Image size 2352x1568; 45° FOV; fundus photo.
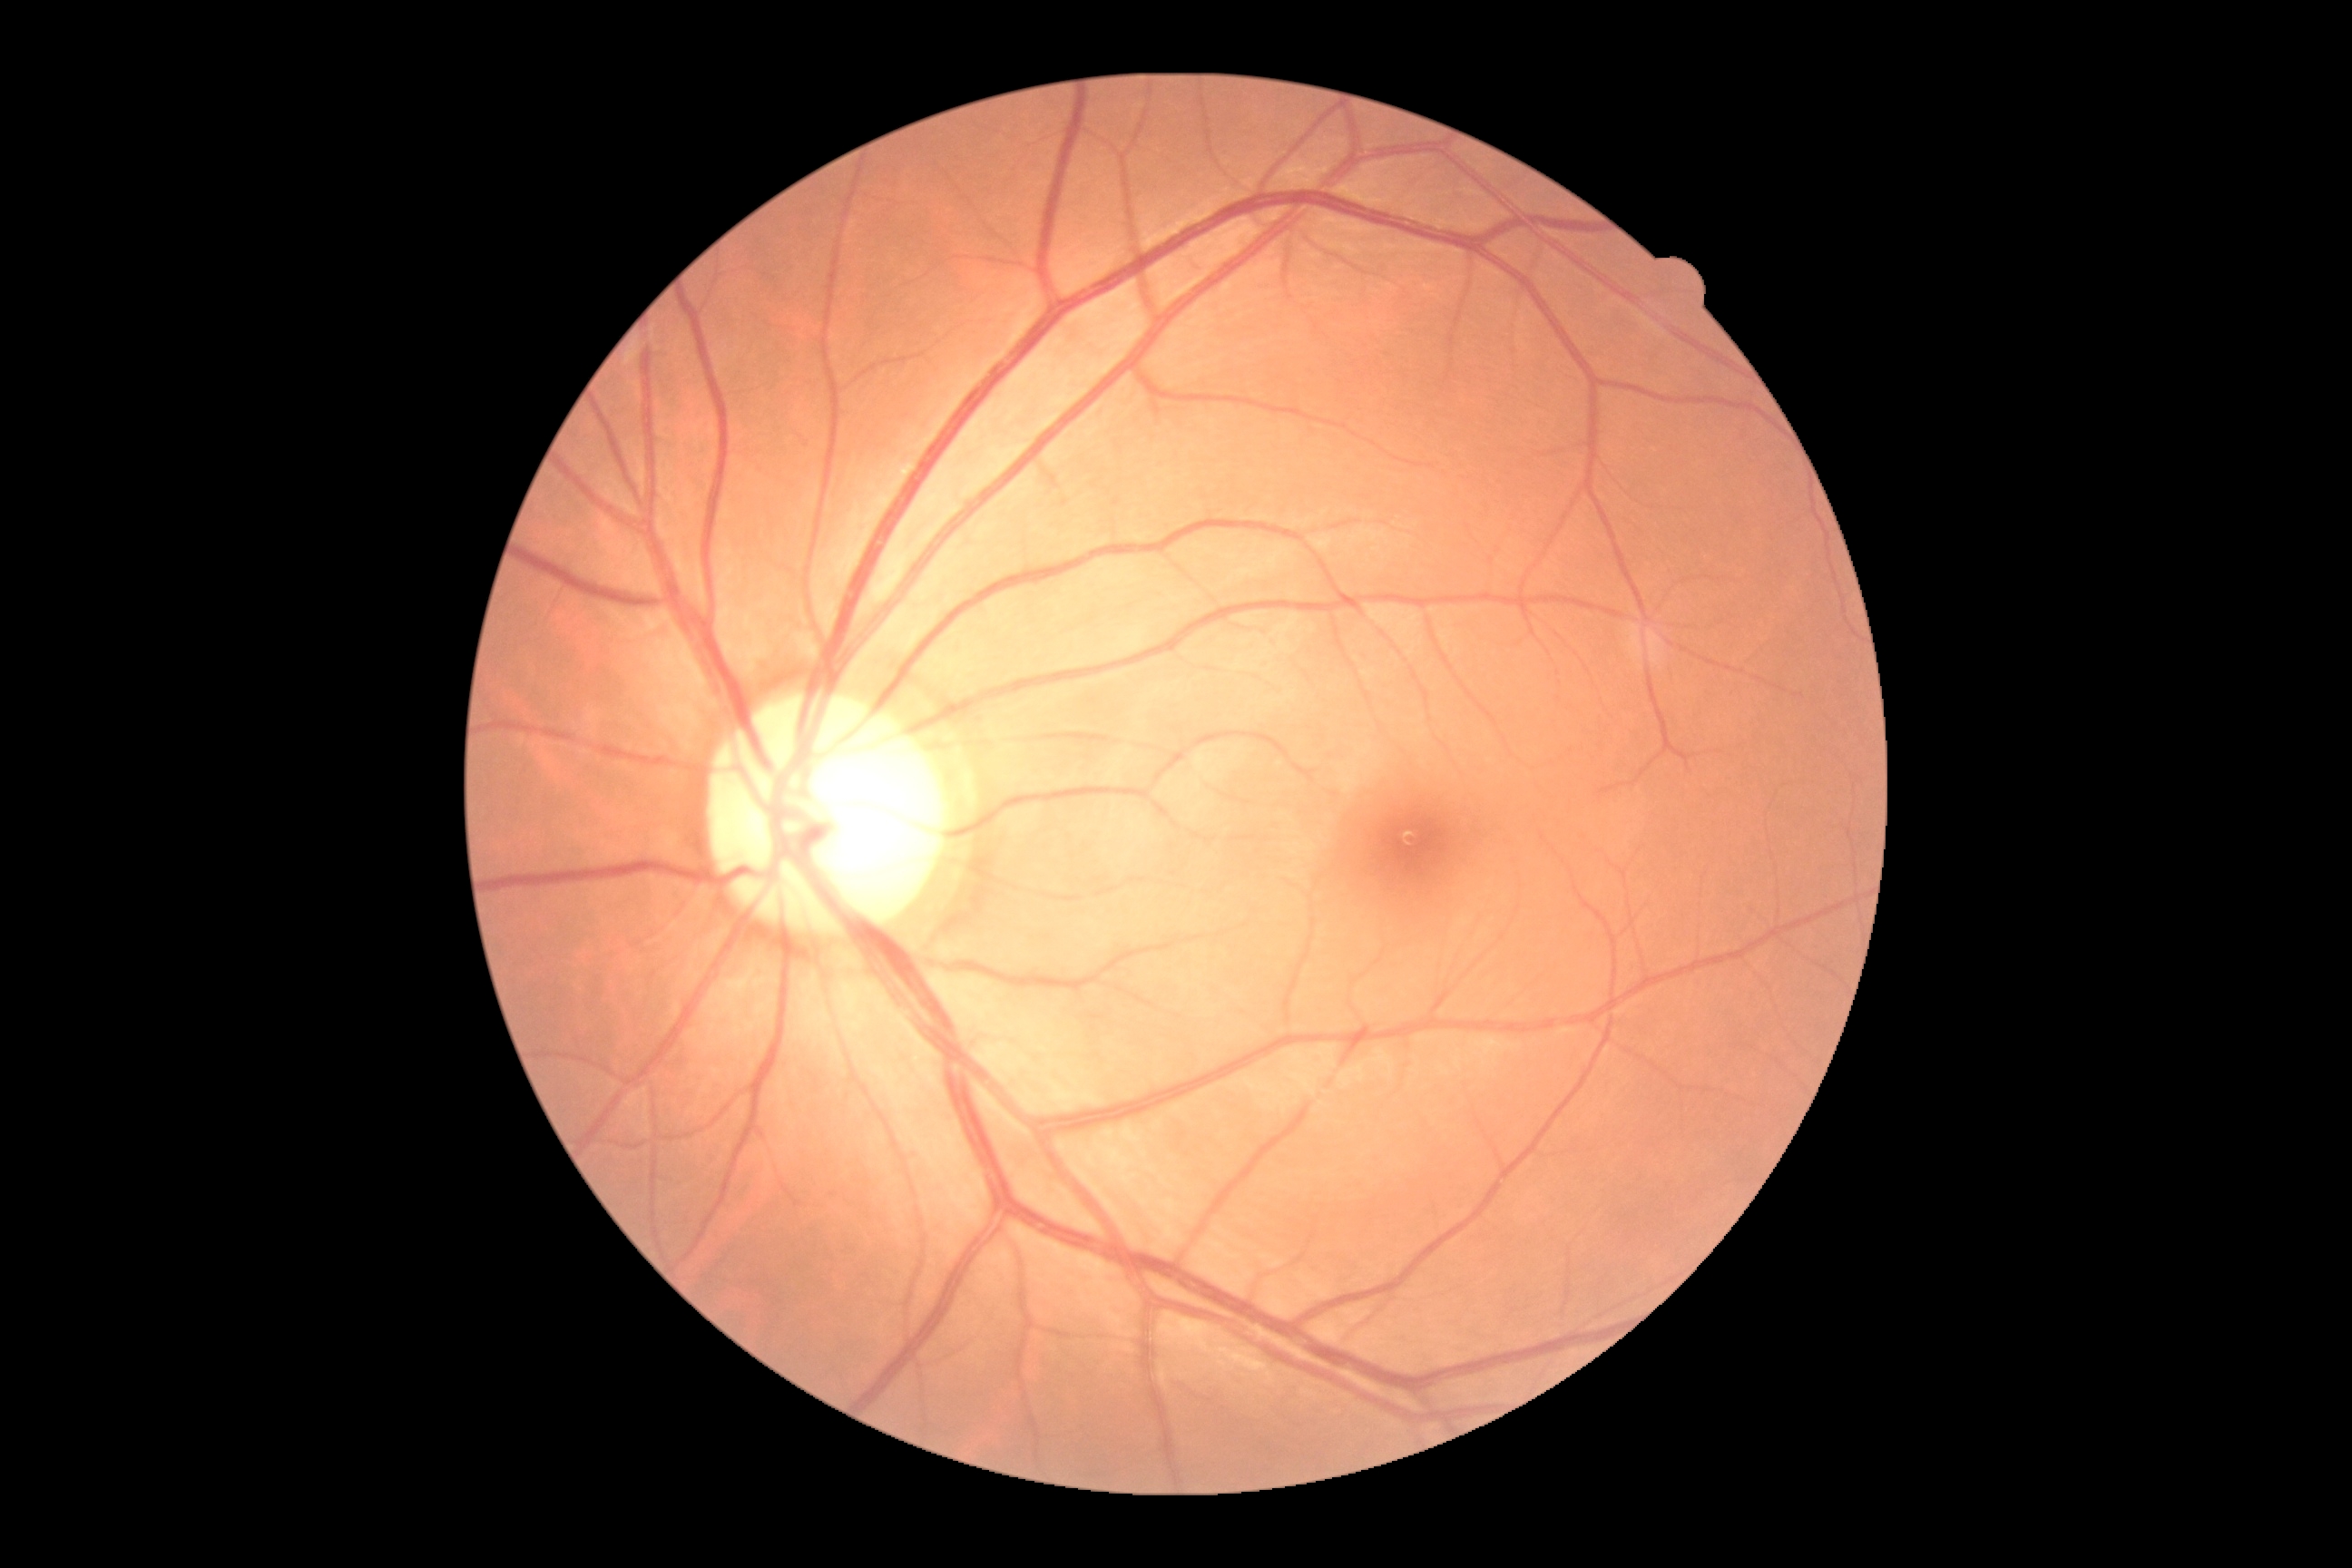
DR severity: 0/4.